No pharmacologic dilation · diabetic retinopathy graded by the modified Davis classification: 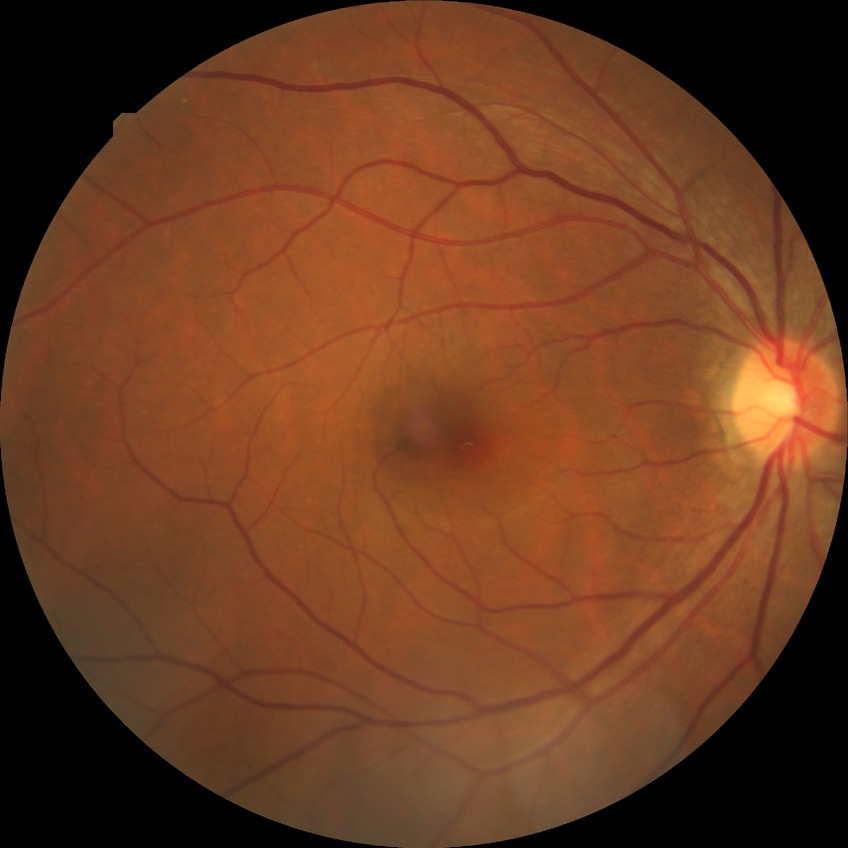

Davis stage is NDR. No signs of diabetic retinopathy.